Acquired with a Topcon TRC-50DX · captured after pupil dilation:
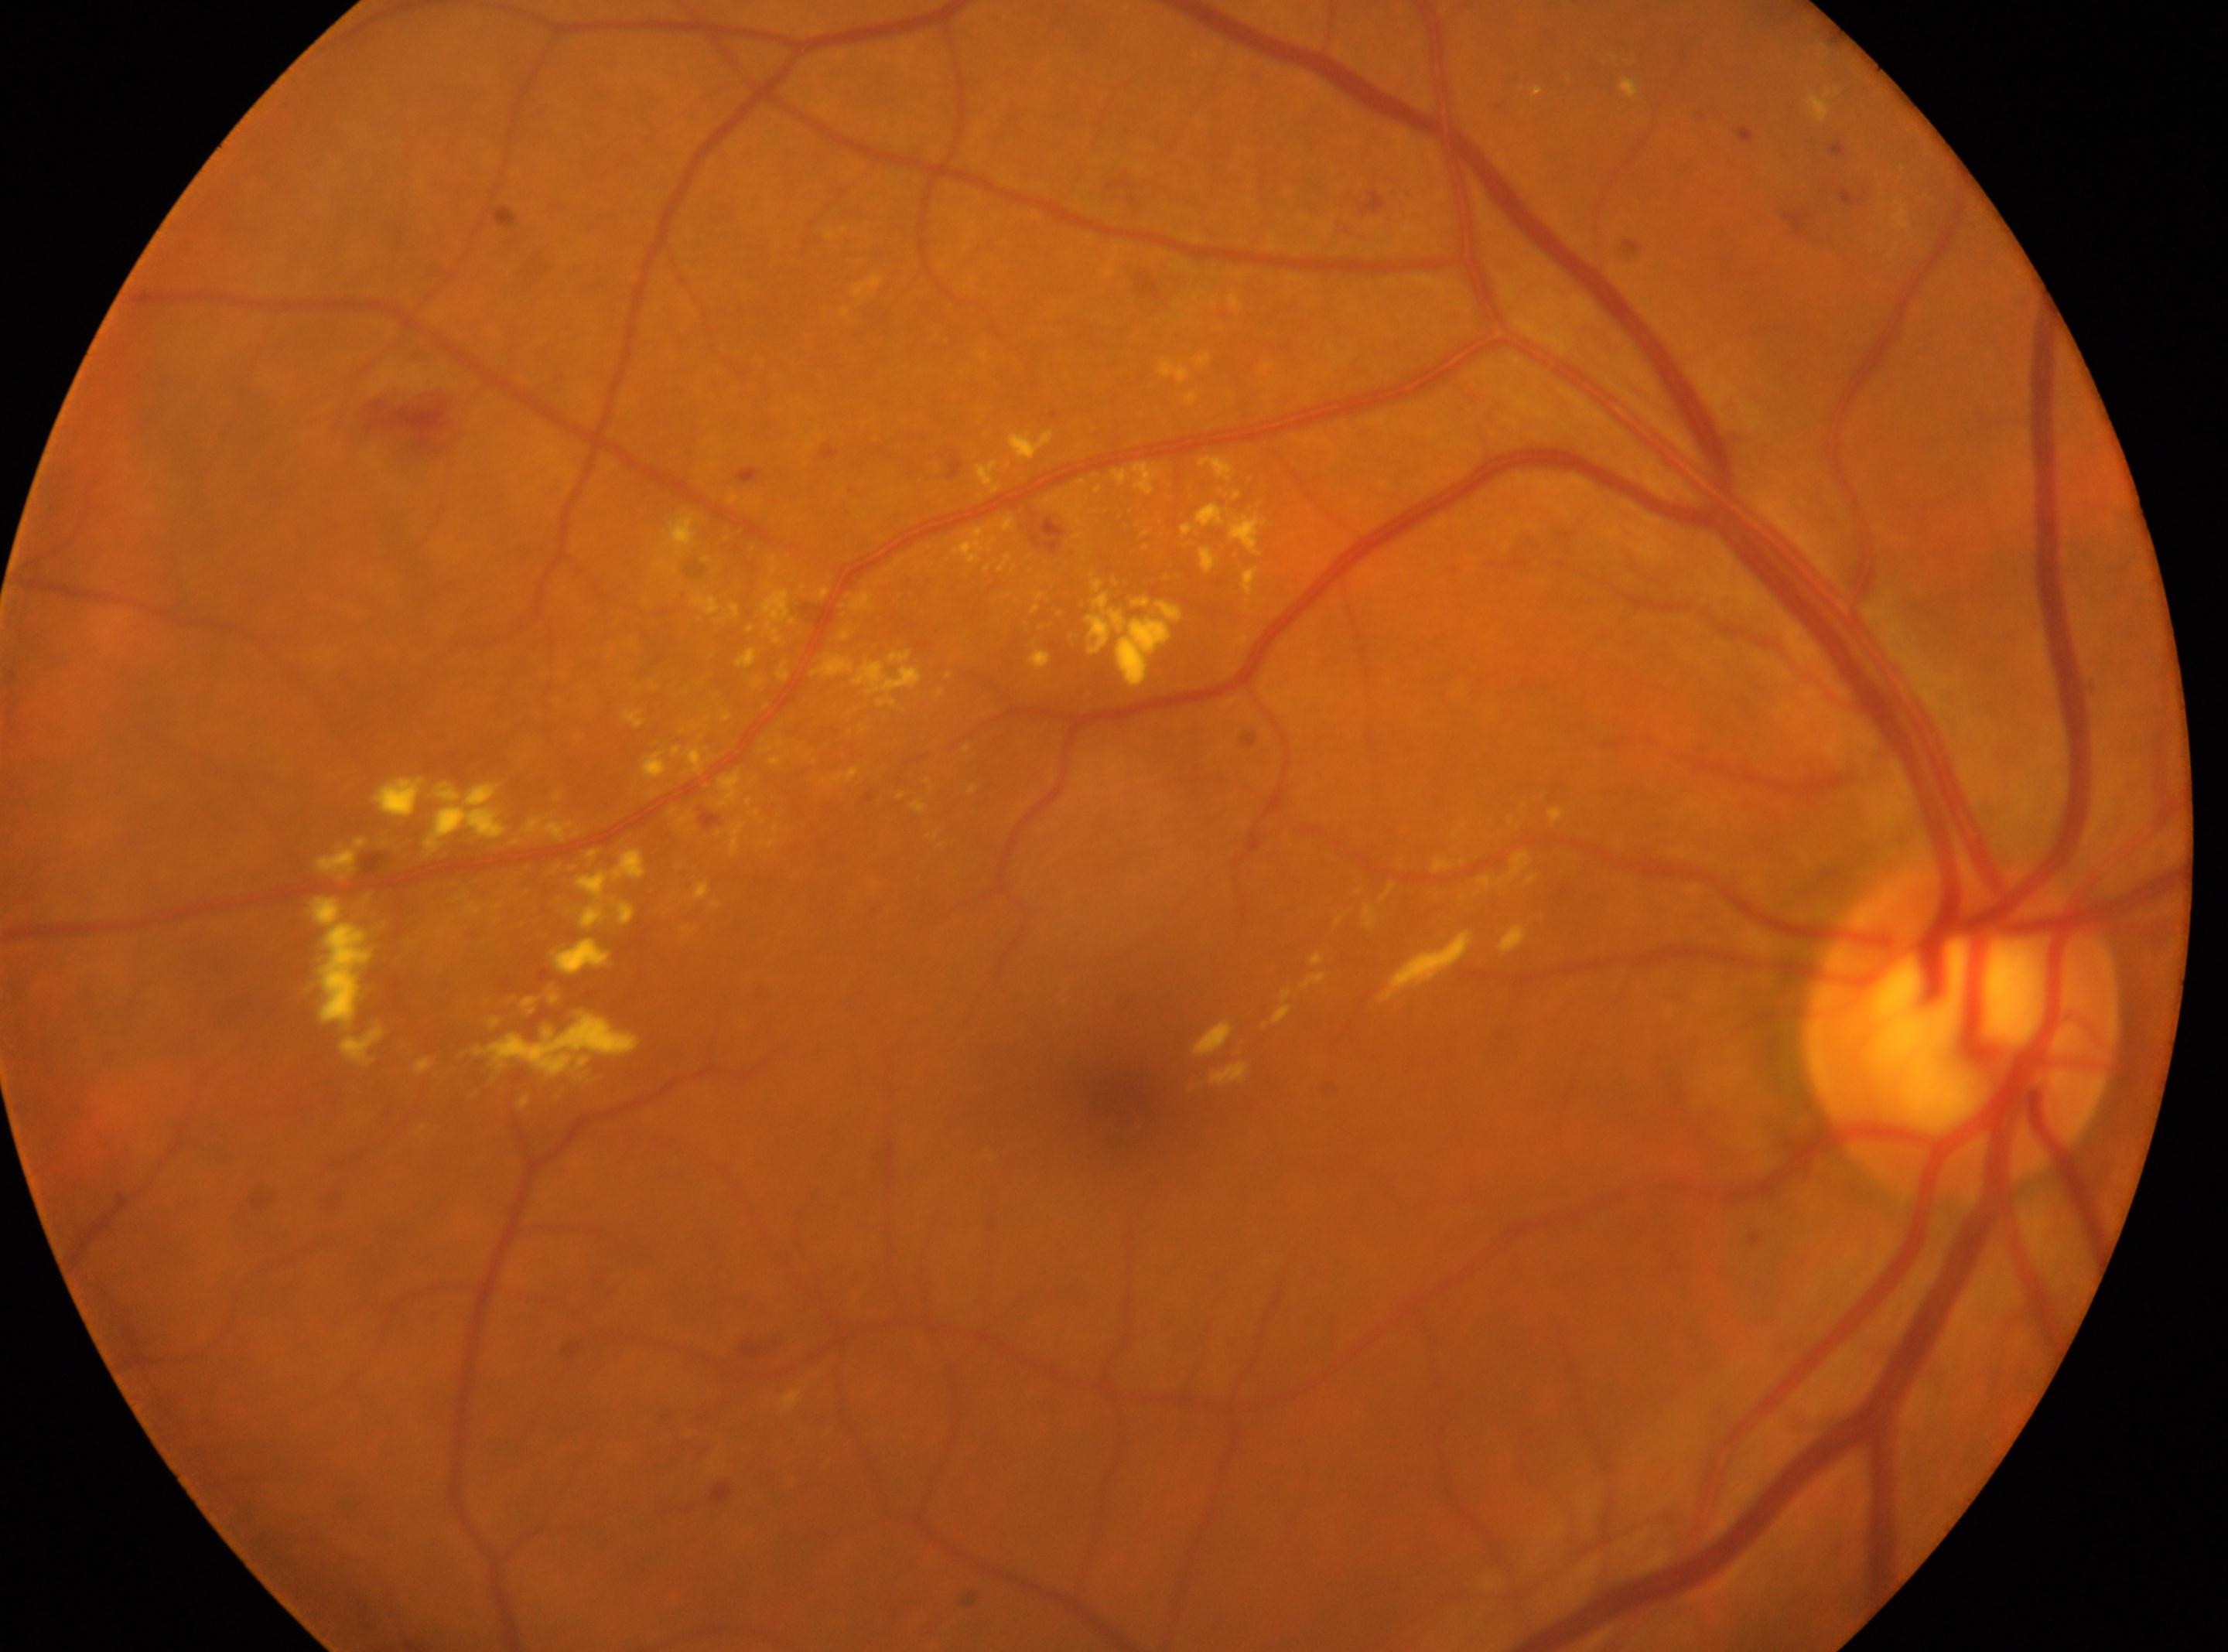
| field | value |
|---|---|
| laterality | right |
| diabetic retinopathy severity | 2/4 |
| macula center | (x=1122, y=1094) |
| optic disk | (x=1960, y=1029) |